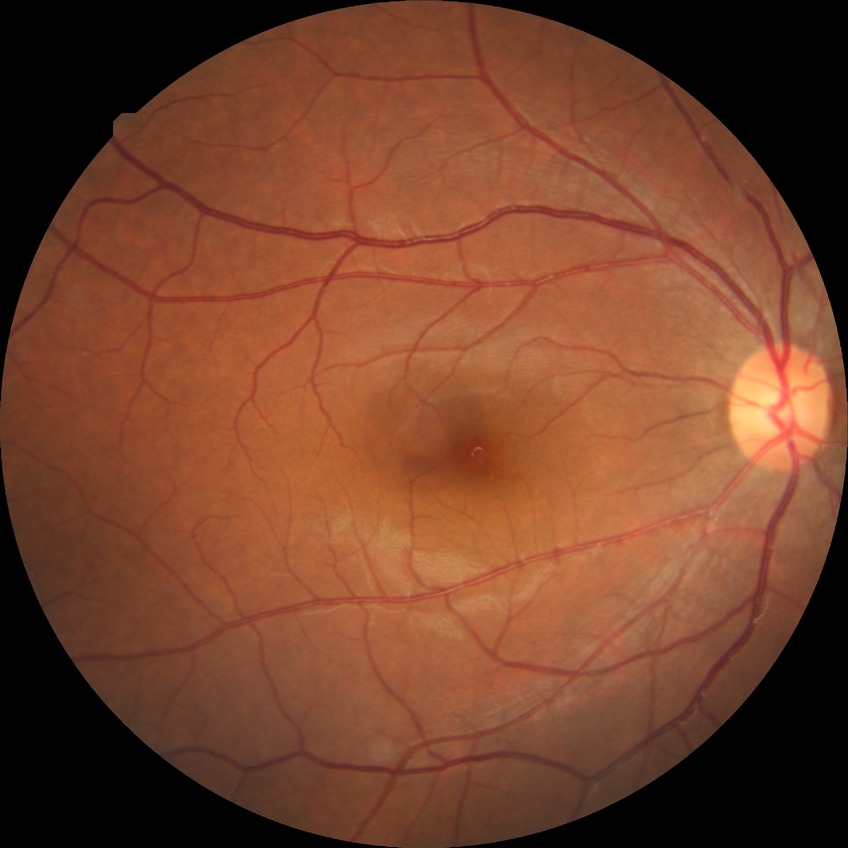
diabetic retinopathy stage: no diabetic retinopathy.